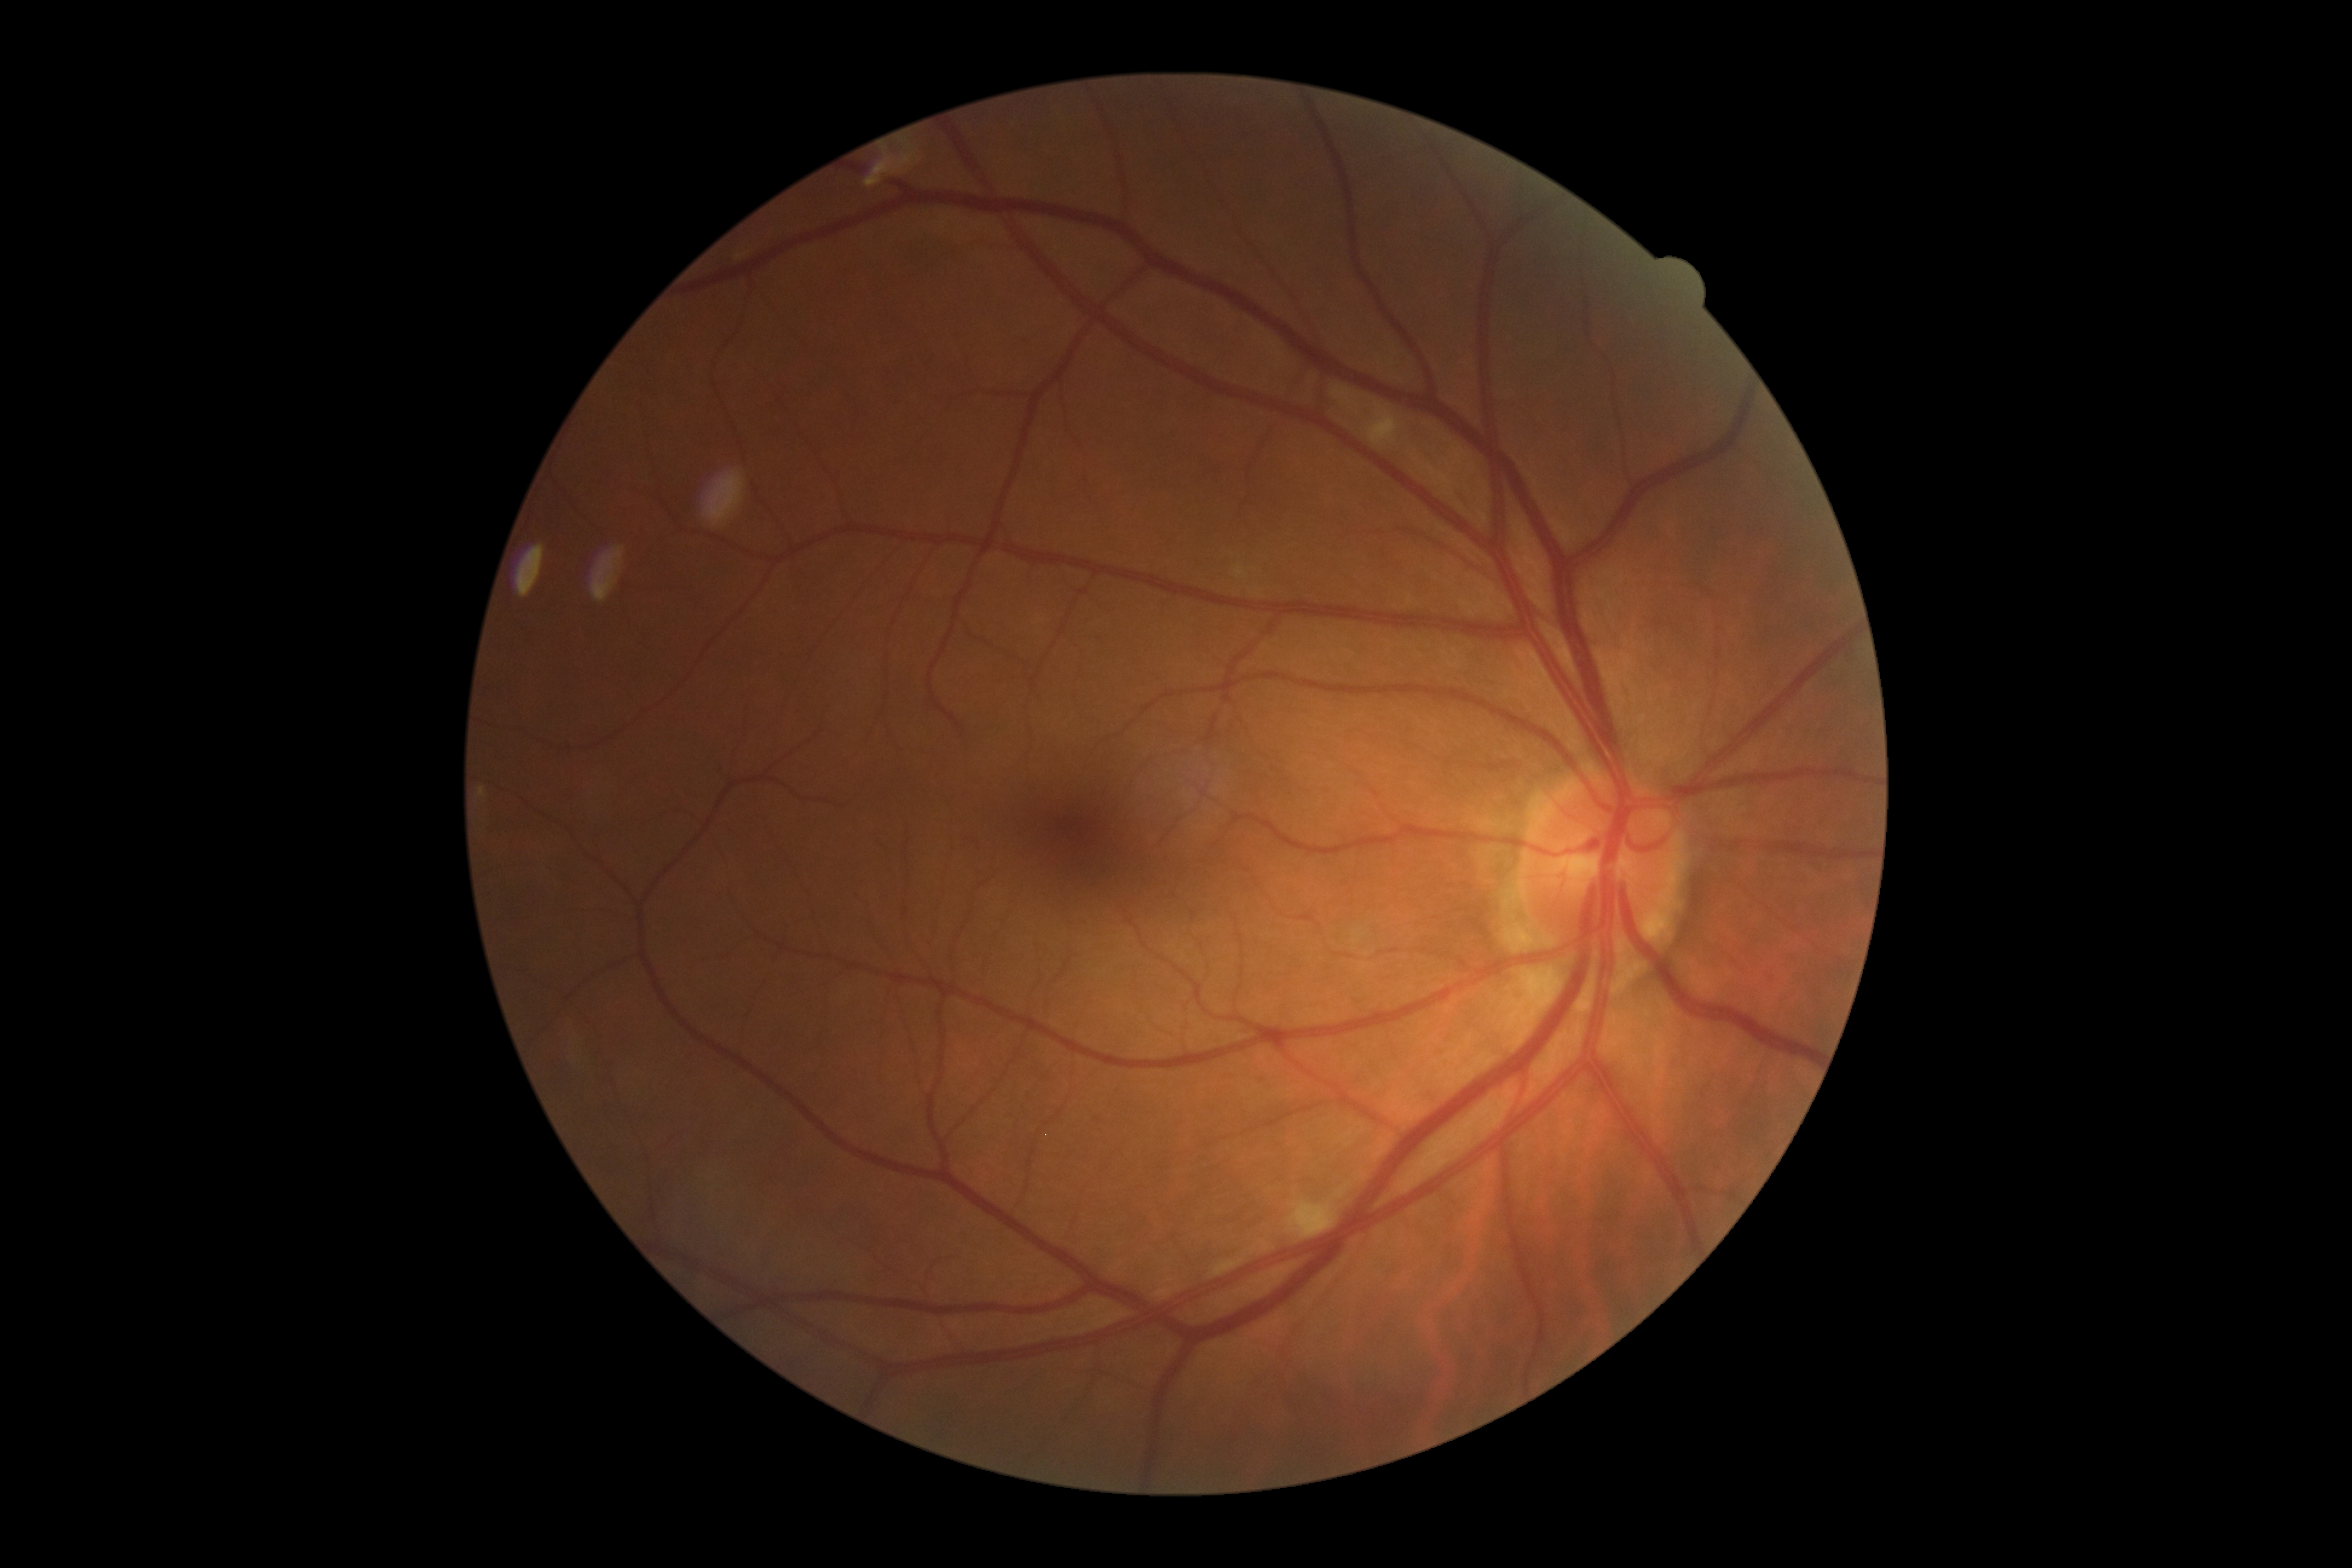 {"dr_grade": "2/4"}